Infant wide-field fundus photograph · 1440x1080:
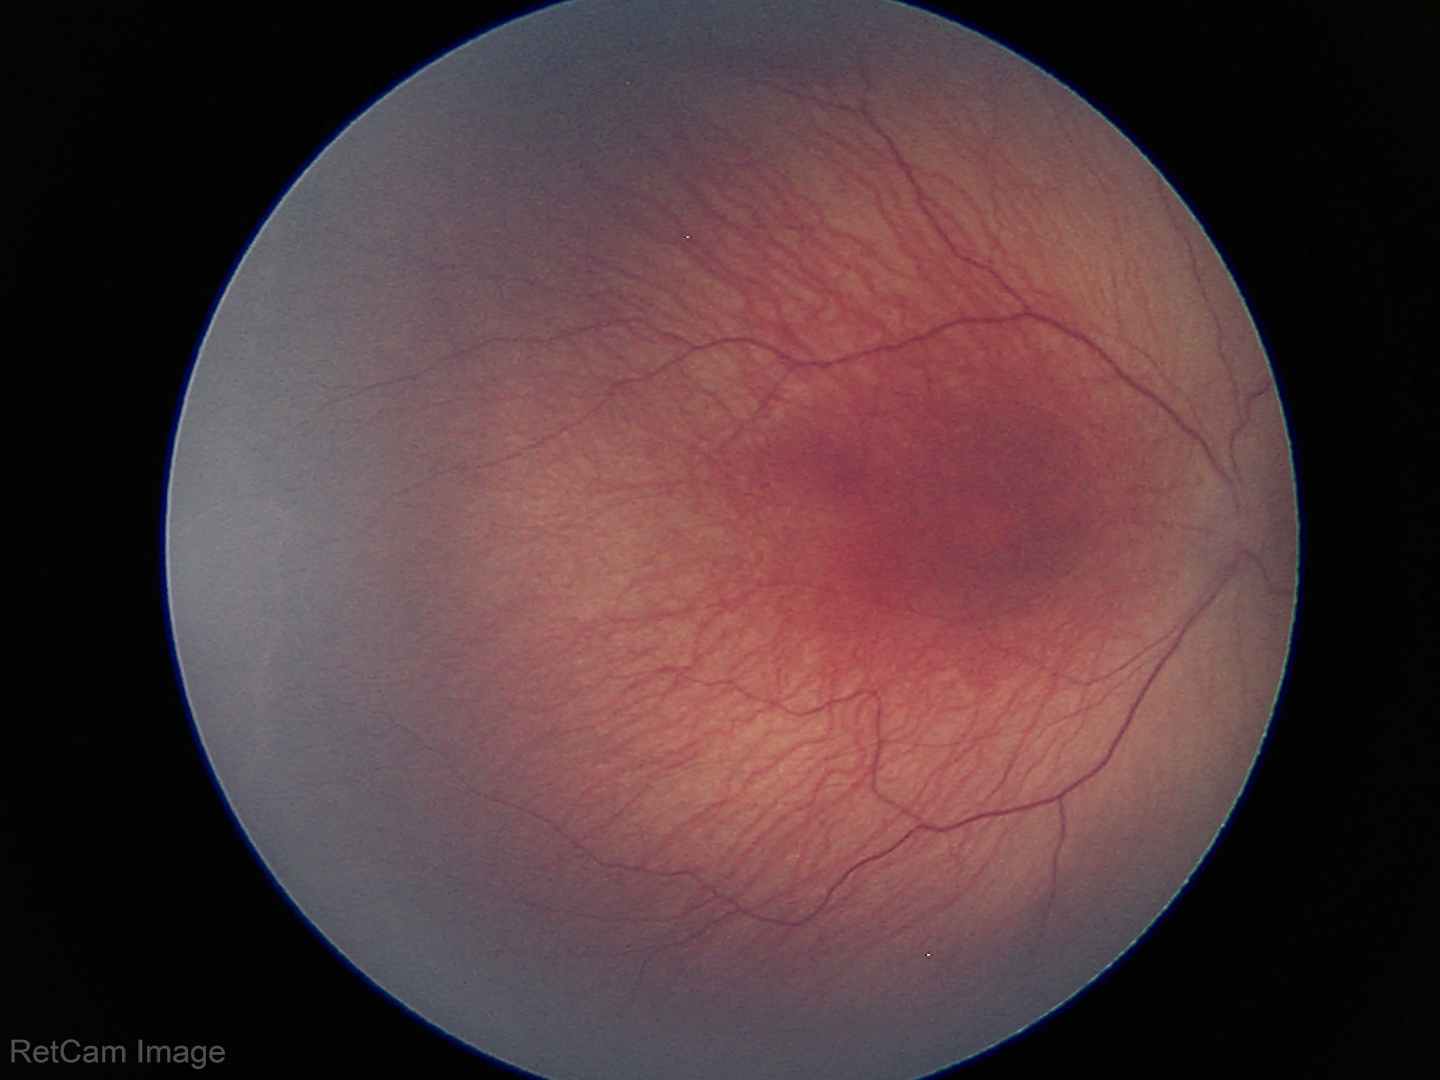
Diagnosis from this screening exam: retinopathy of prematurity stage 1 — demarcation line between vascular and avascular retina. Without plus disease.